RetCam wide-field infant fundus image · camera: Natus RetCam Envision (130° FOV).
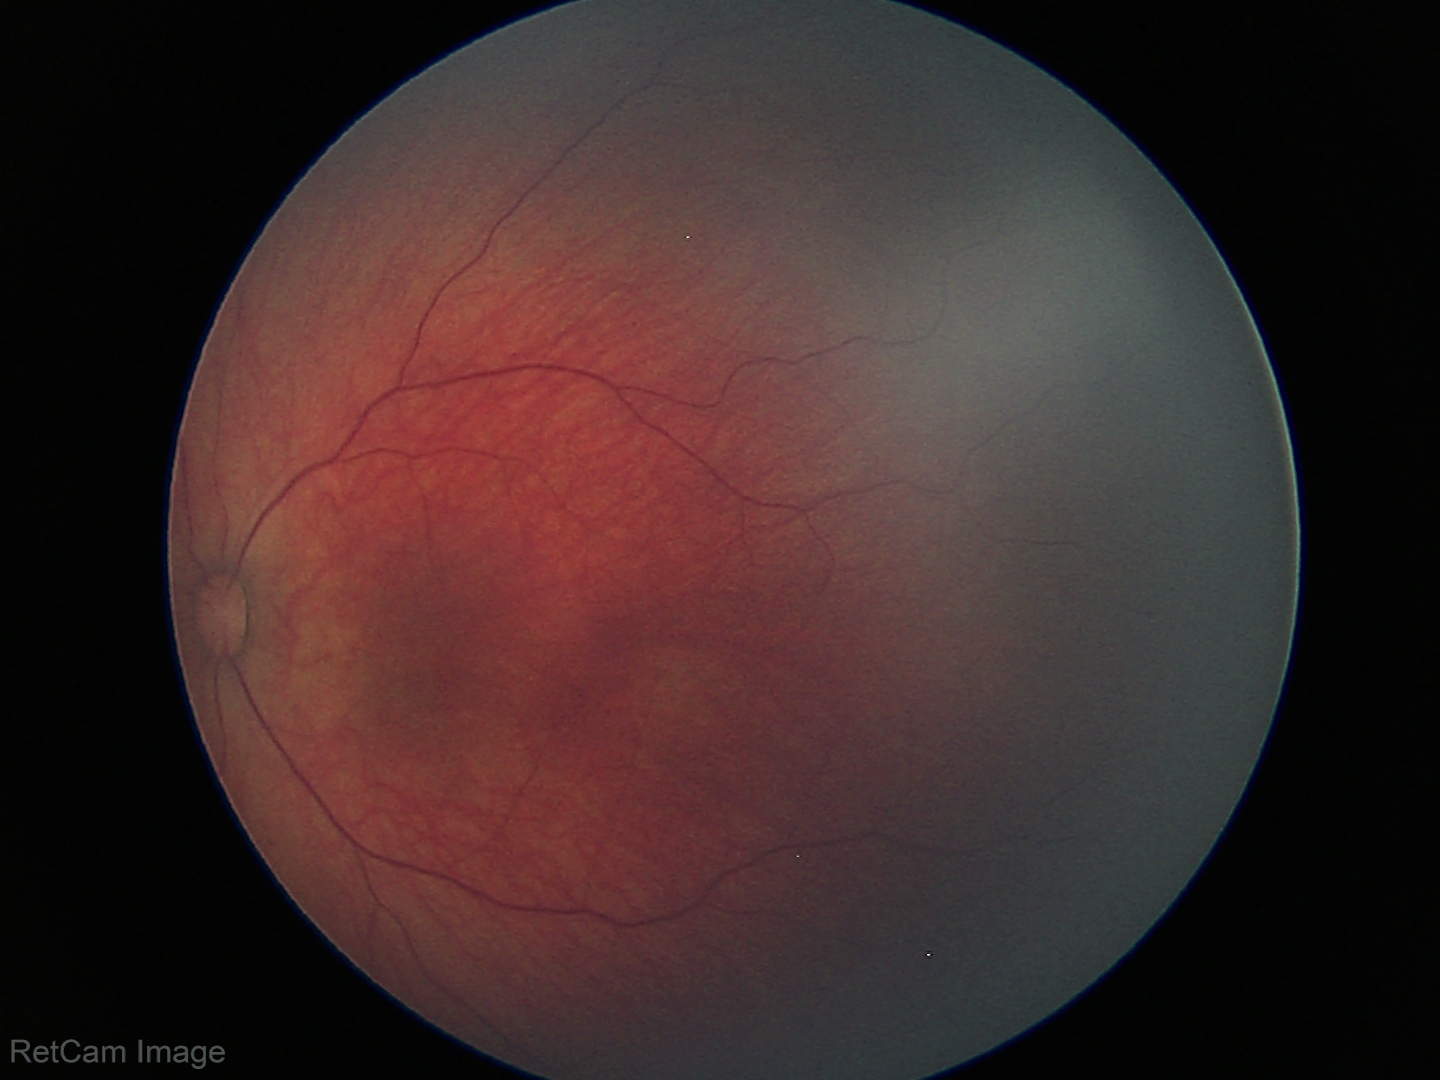

Diagnosis from this screening exam: retinal hemorrhages.